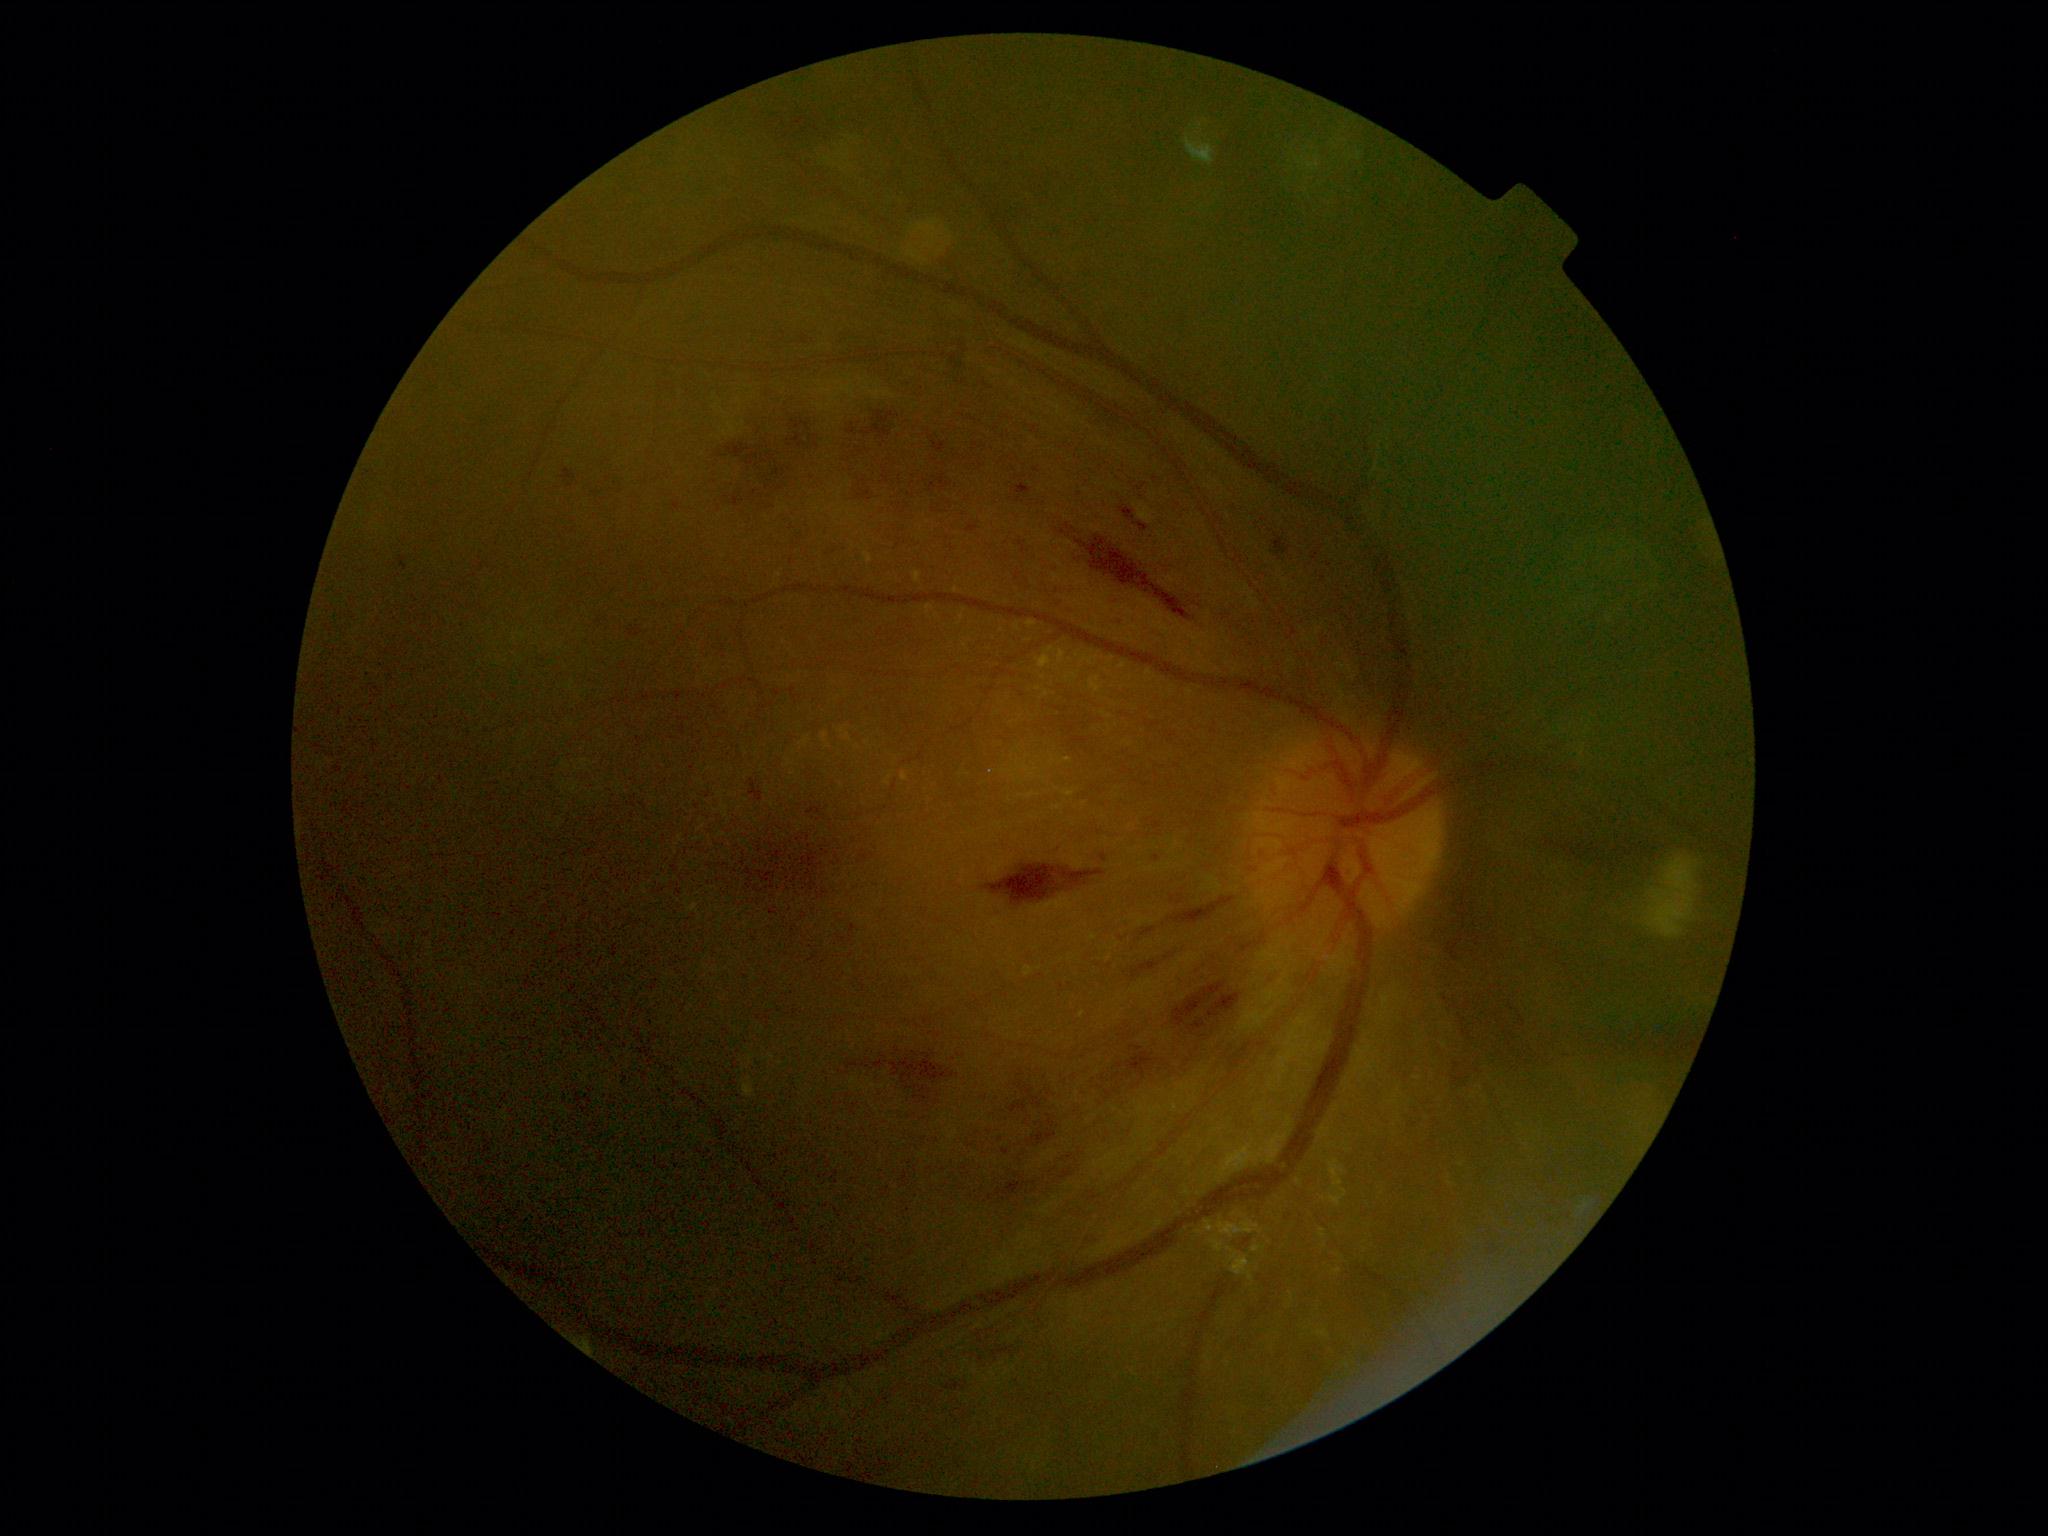 • DR — 3/4 — more than 20 intraretinal hemorrhages in each of 4 quadrants, definite venous beading in 2 or more quadrants, or prominent intraretinal microvascular abnormalities in 1 or more quadrants, with no signs of proliferative retinopathy
• DR class — non-proliferative diabetic retinopathy